Remidio Fundus on Phone. Color fundus image. Image size 1659x2212
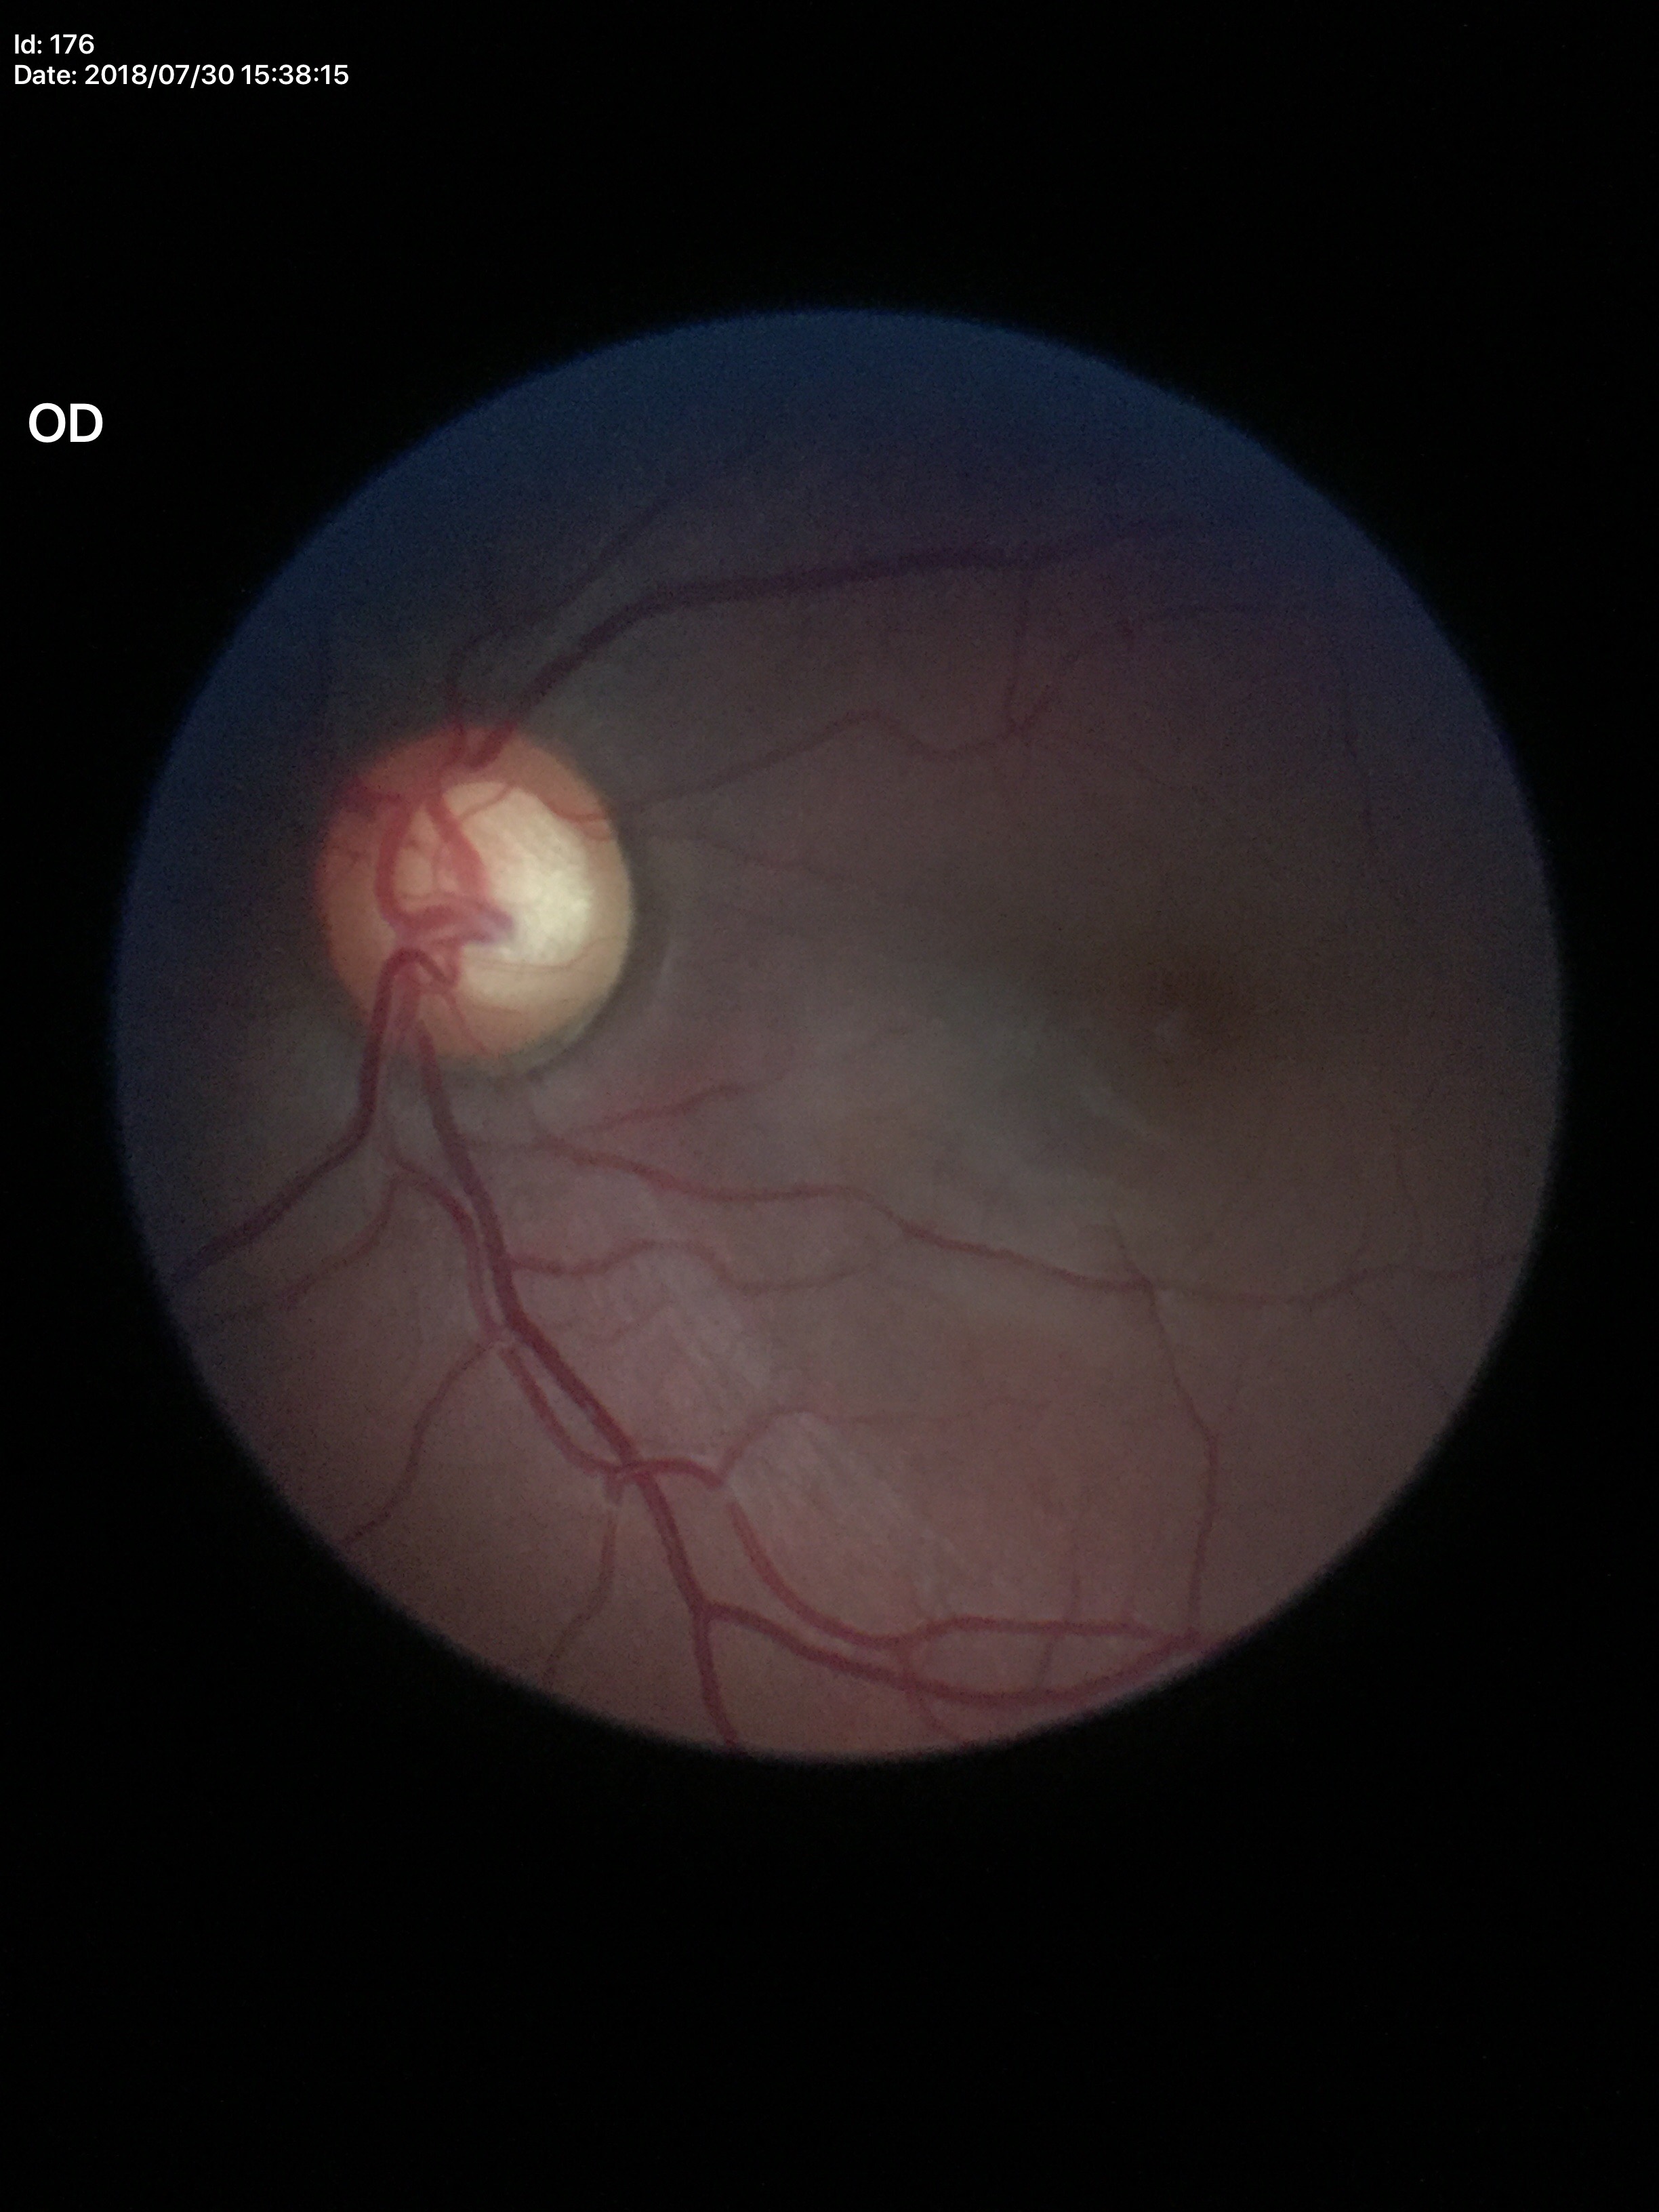 Glaucoma suspect.
Vertical CDR of 0.70.
Area cup-disc ratio is 0.47.